45° FOV; 1932x1910px; CFP.
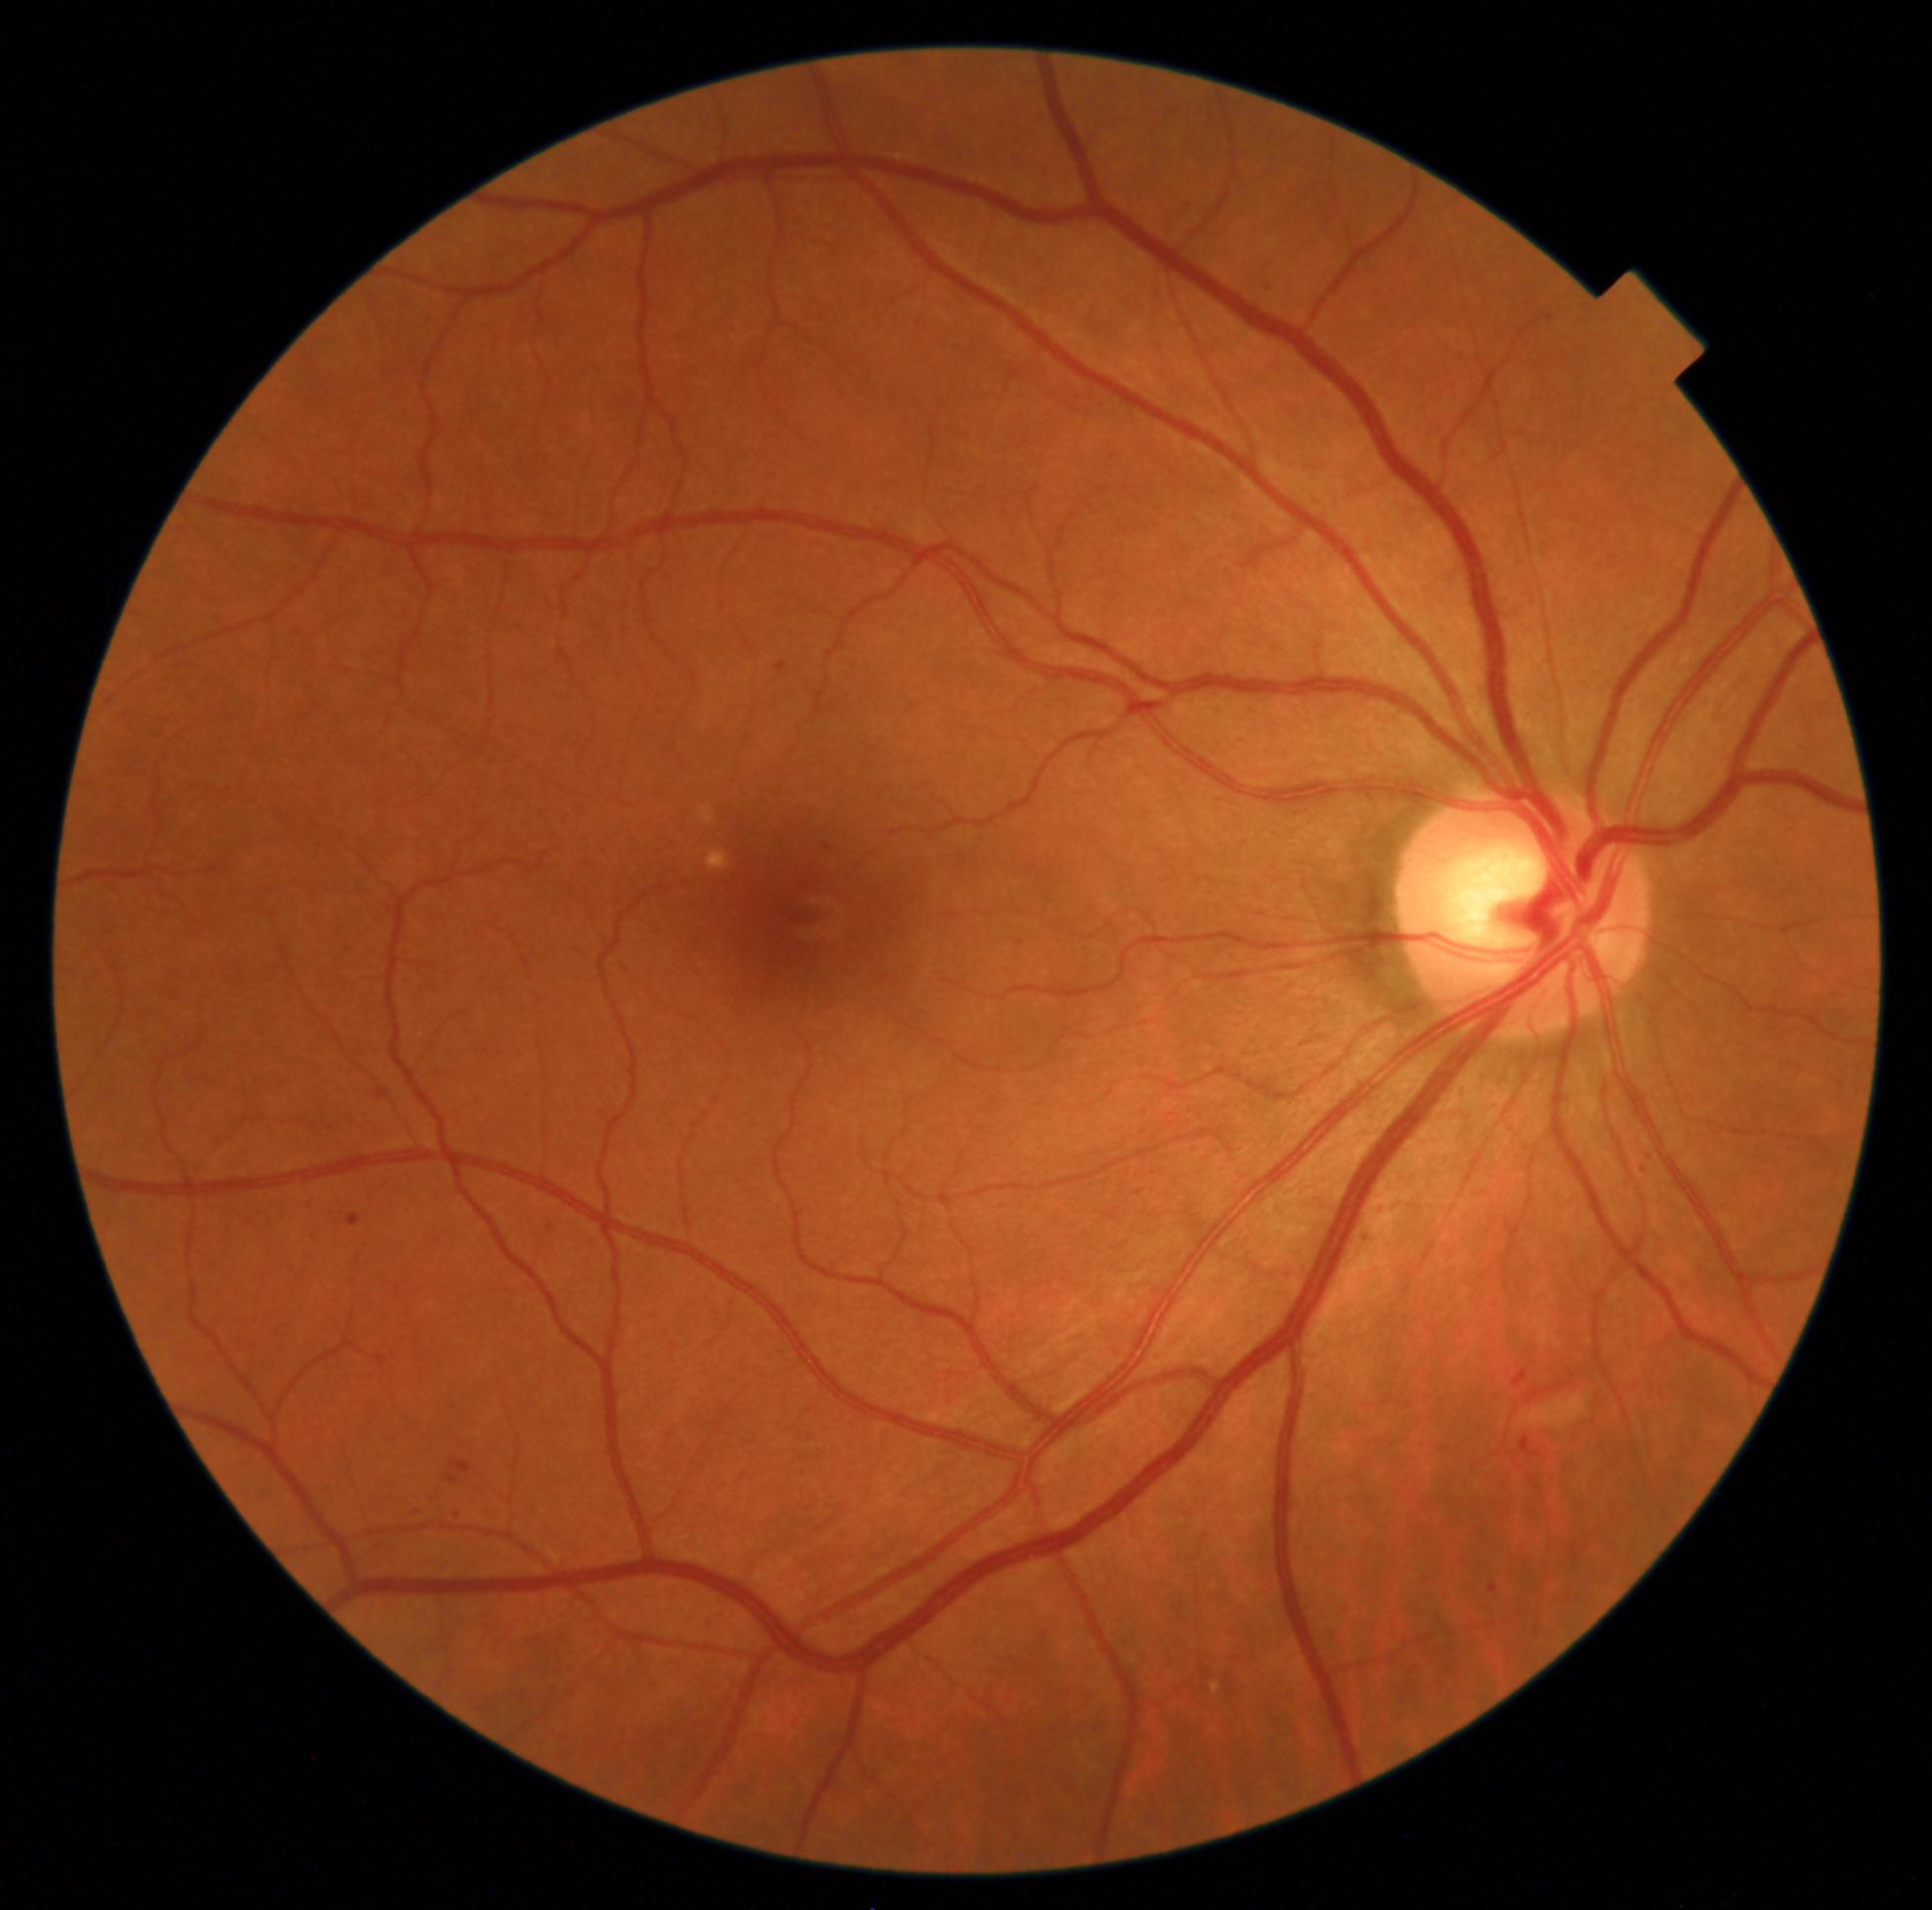

DR stage: grade 2 (moderate NPDR). The retinopathy is classified as non-proliferative diabetic retinopathy.